Image size 2352x1568
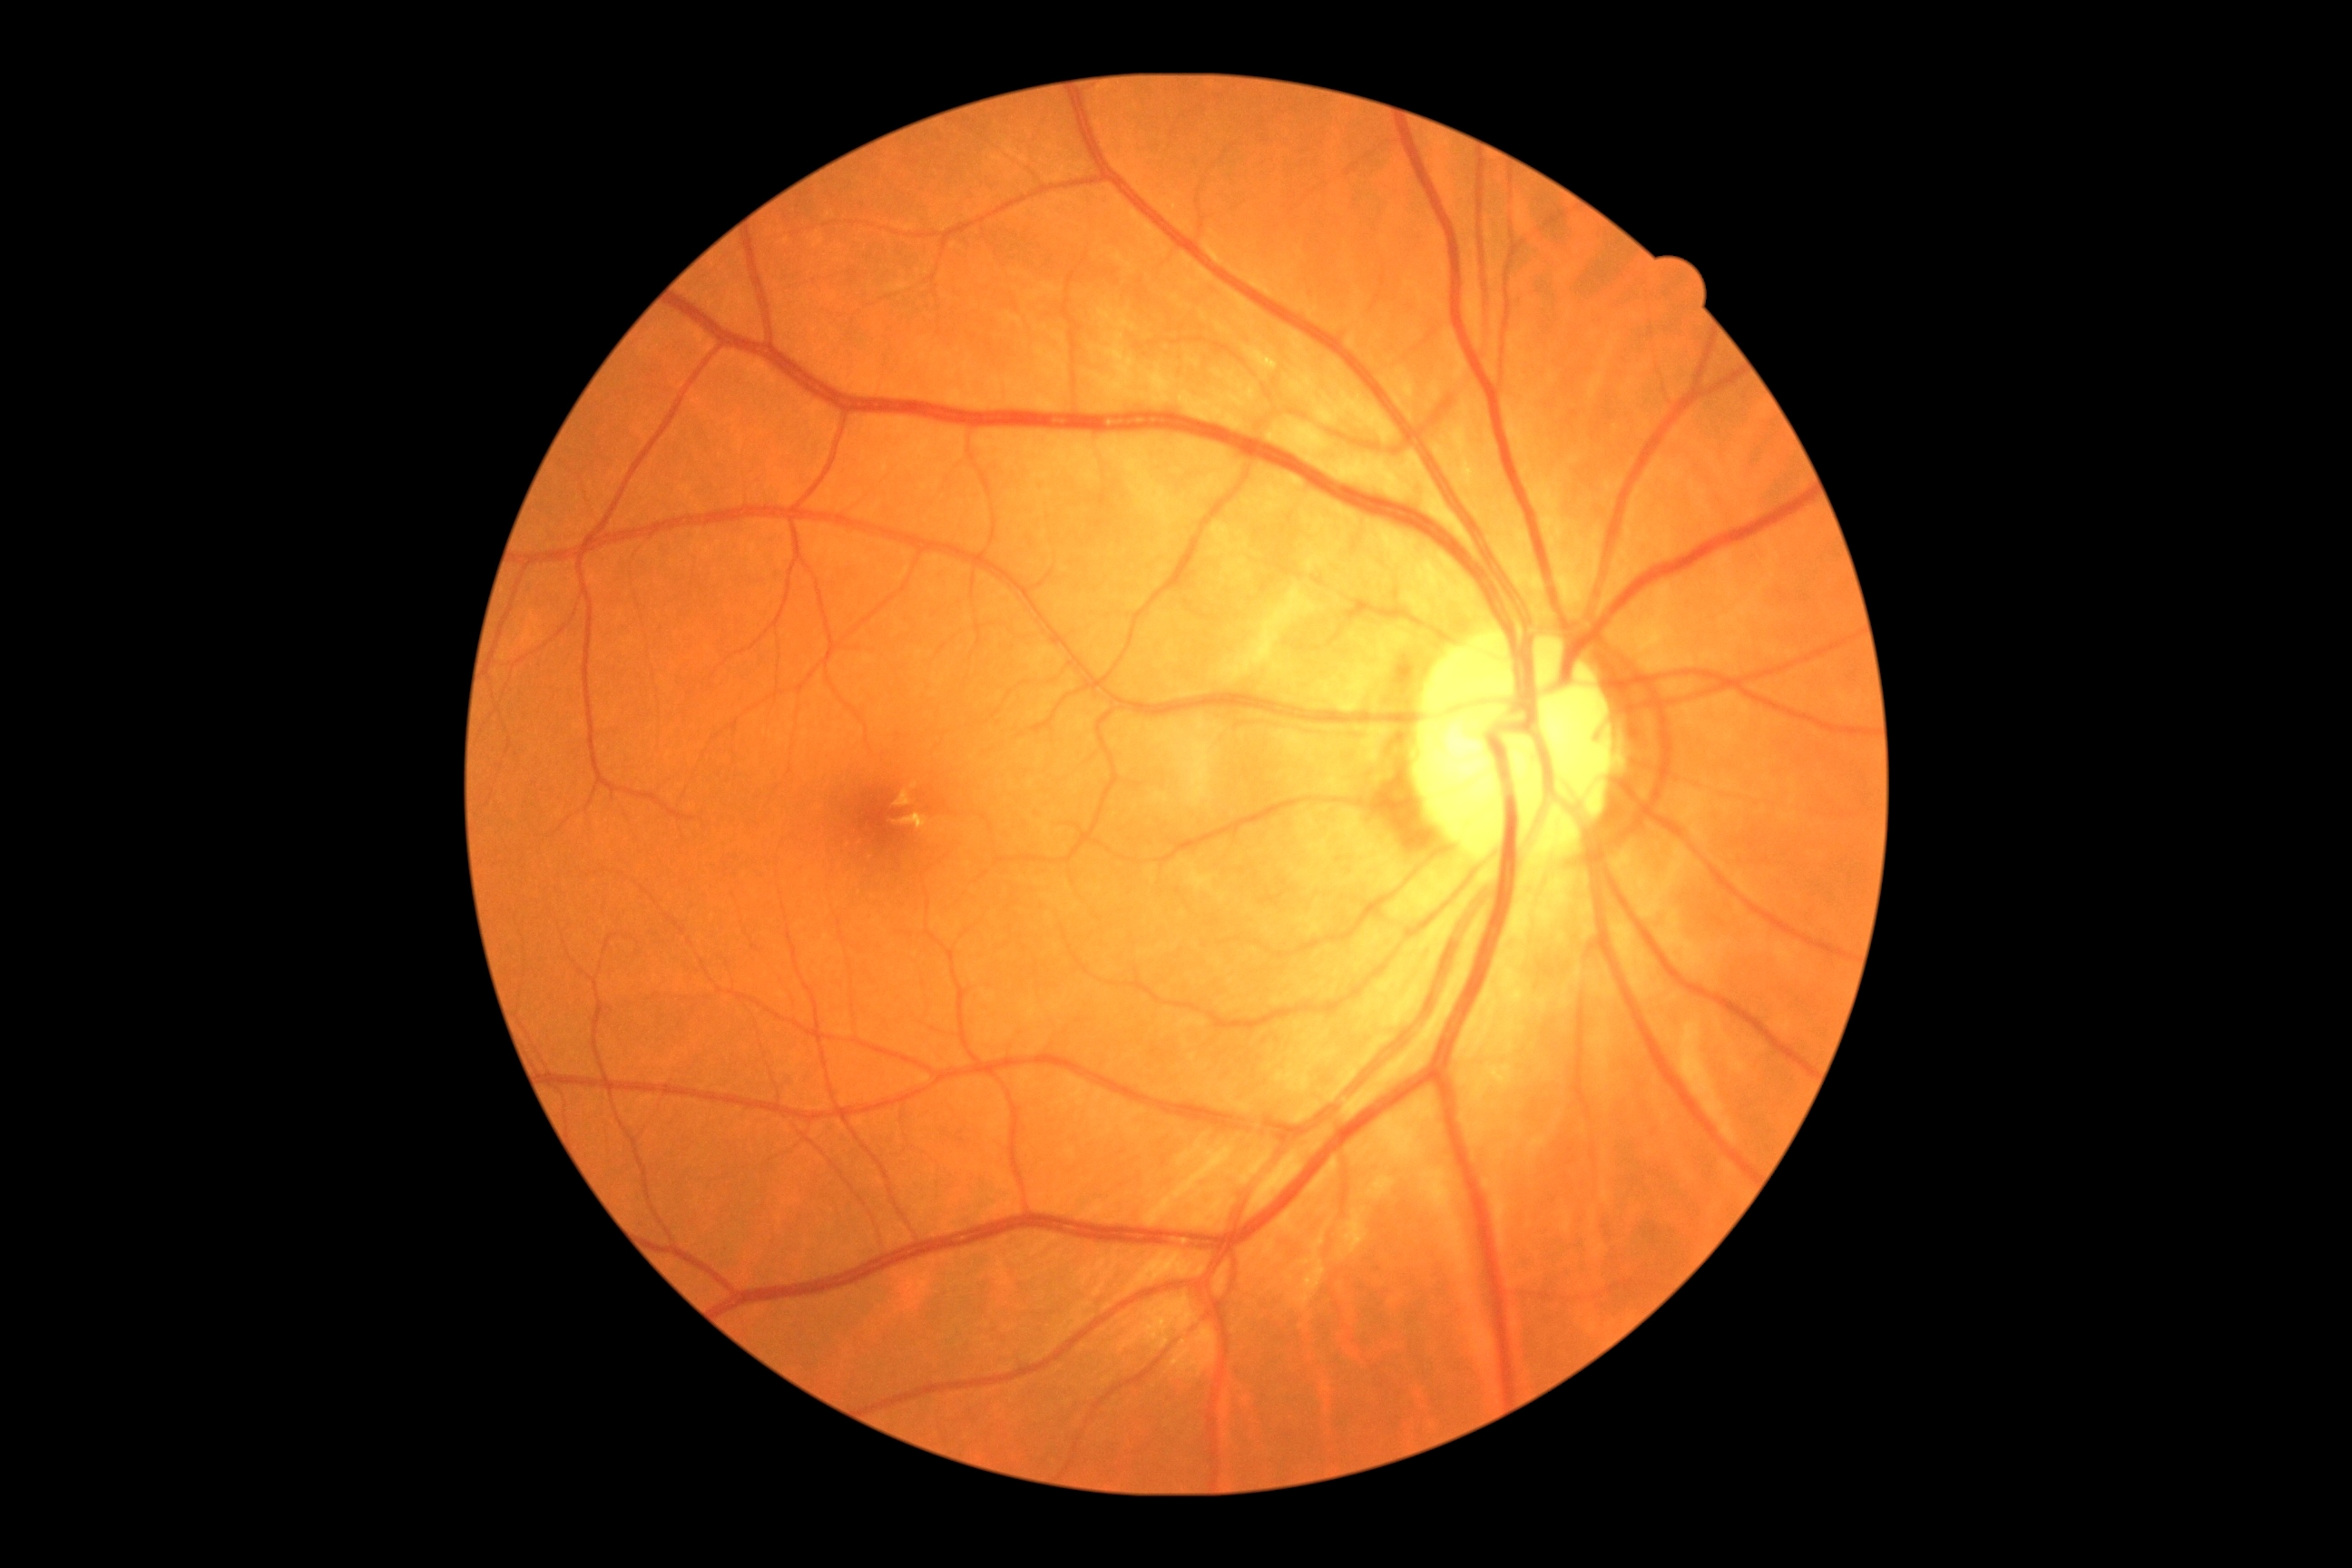

retinopathy: grade 0 (no apparent retinopathy).